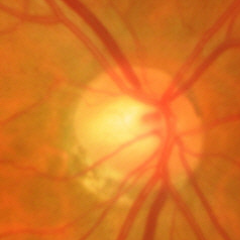

Demonstrates no evidence of glaucoma.